1440 x 1080 pixels · pediatric retinal photograph (wide-field) · acquired on the Natus RetCam Envision: 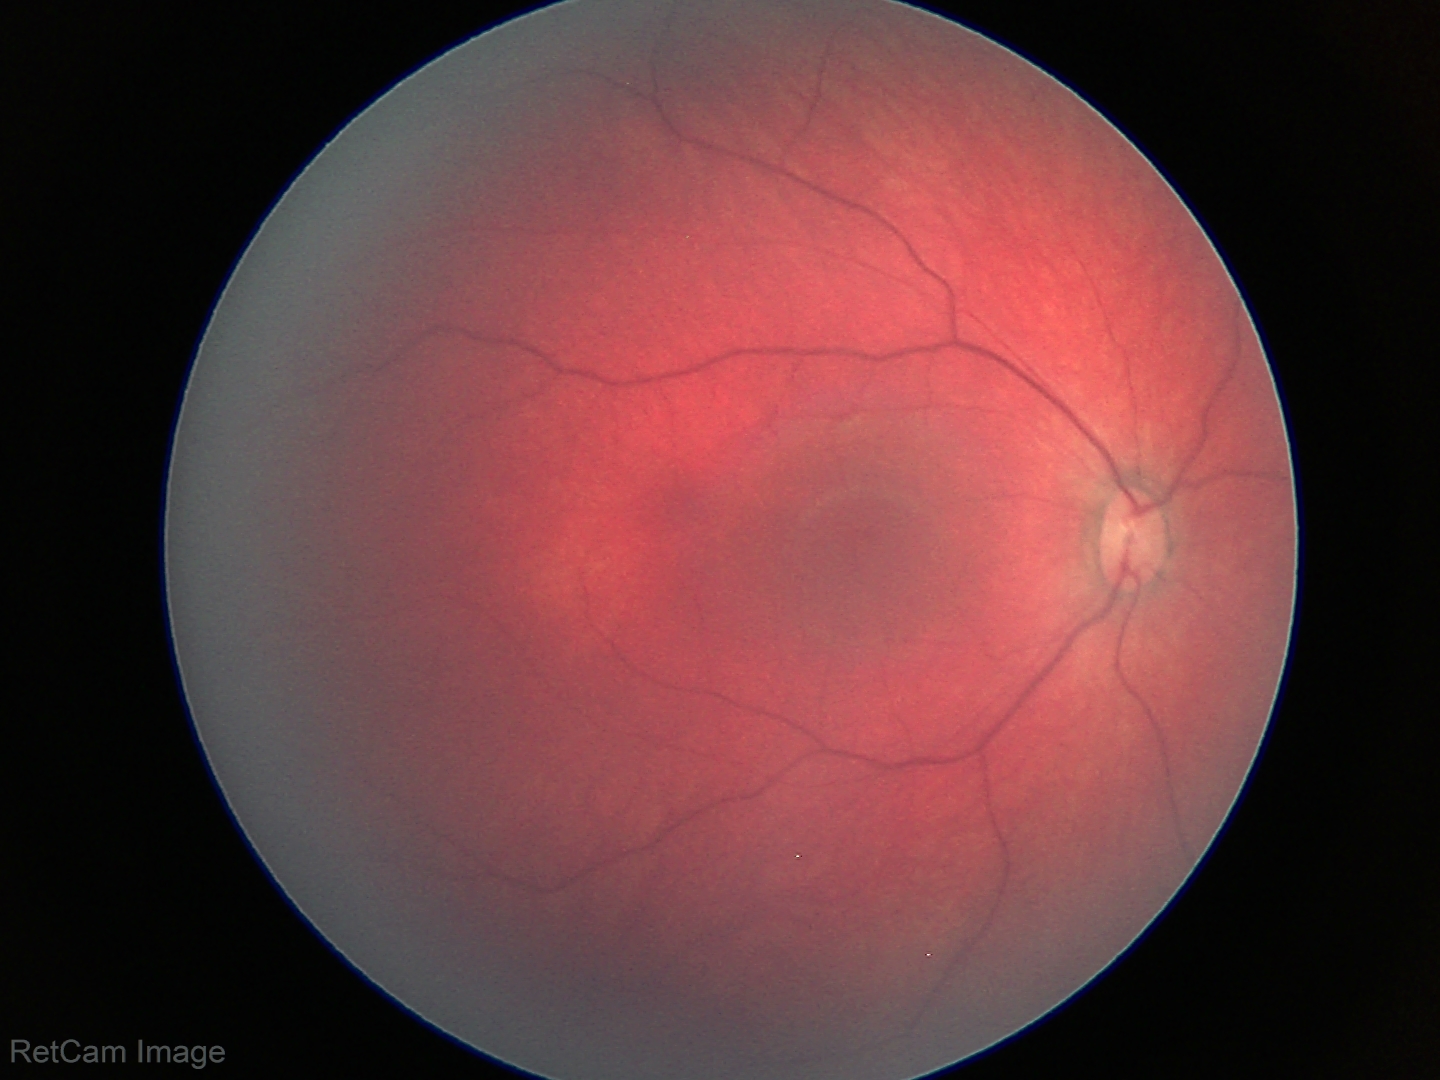

Examination with physiological retinal findings.